Color fundus image — 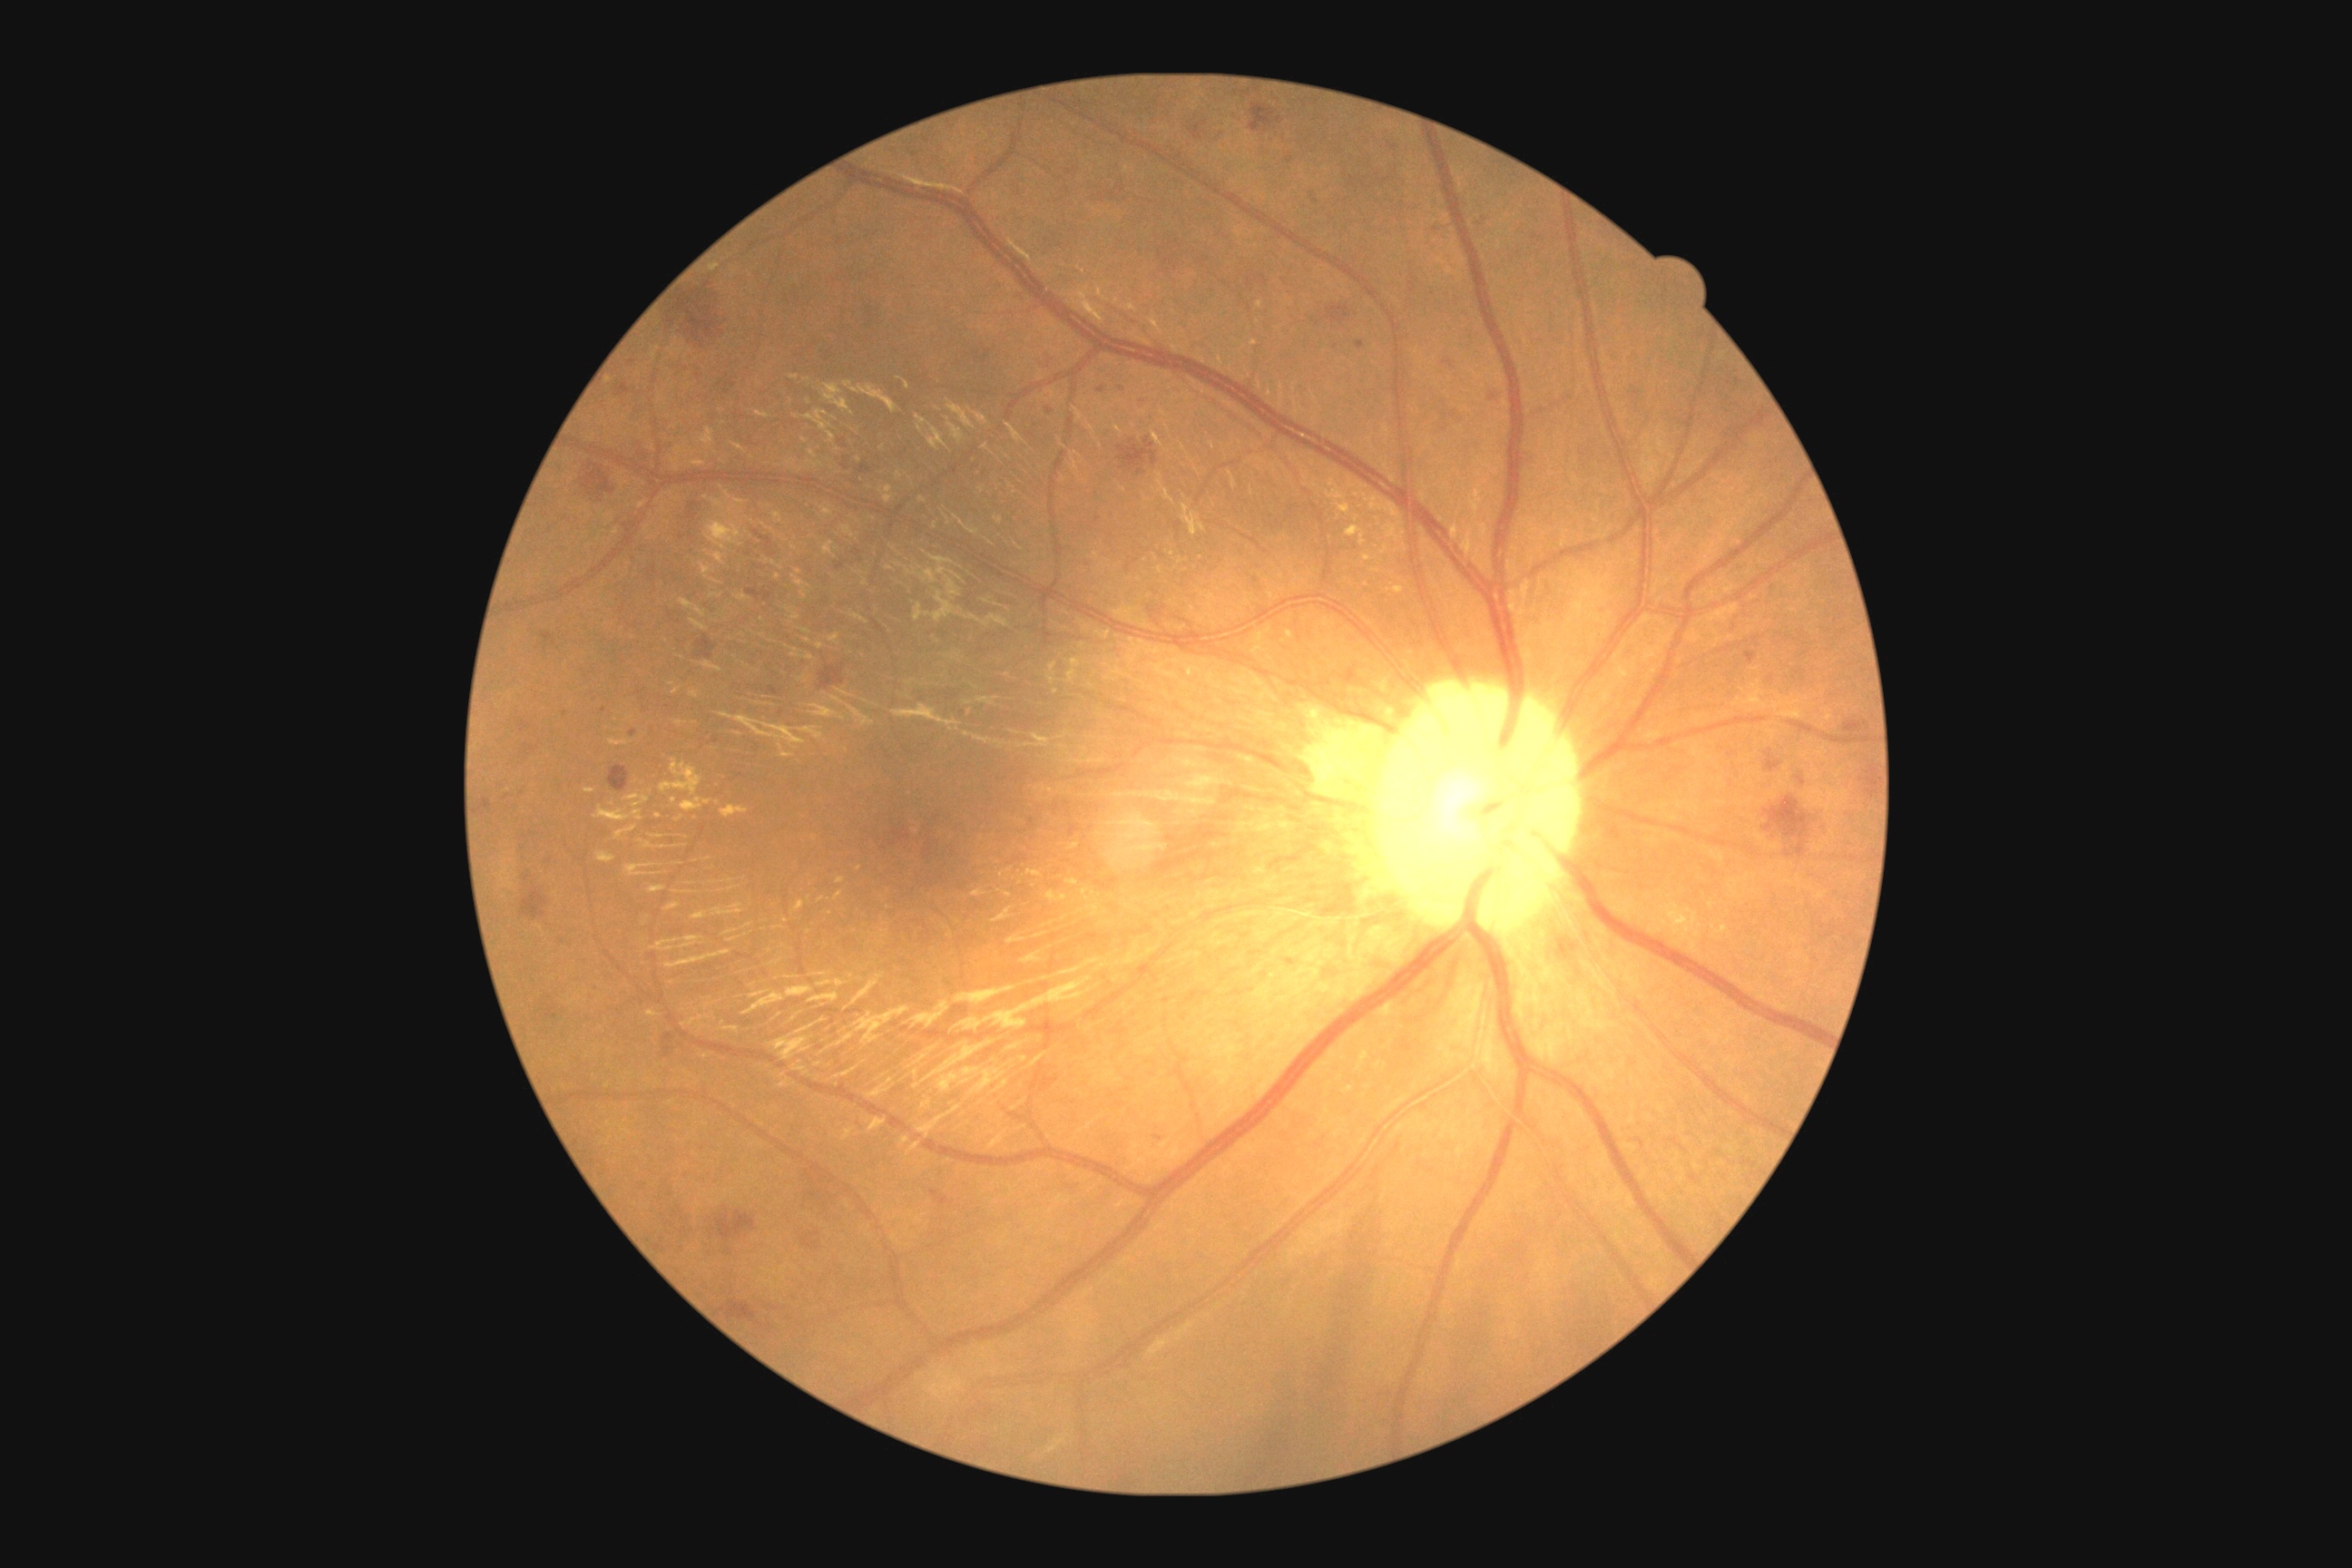 DR grade: 2 — more than just microaneurysms but less than severe NPDR.